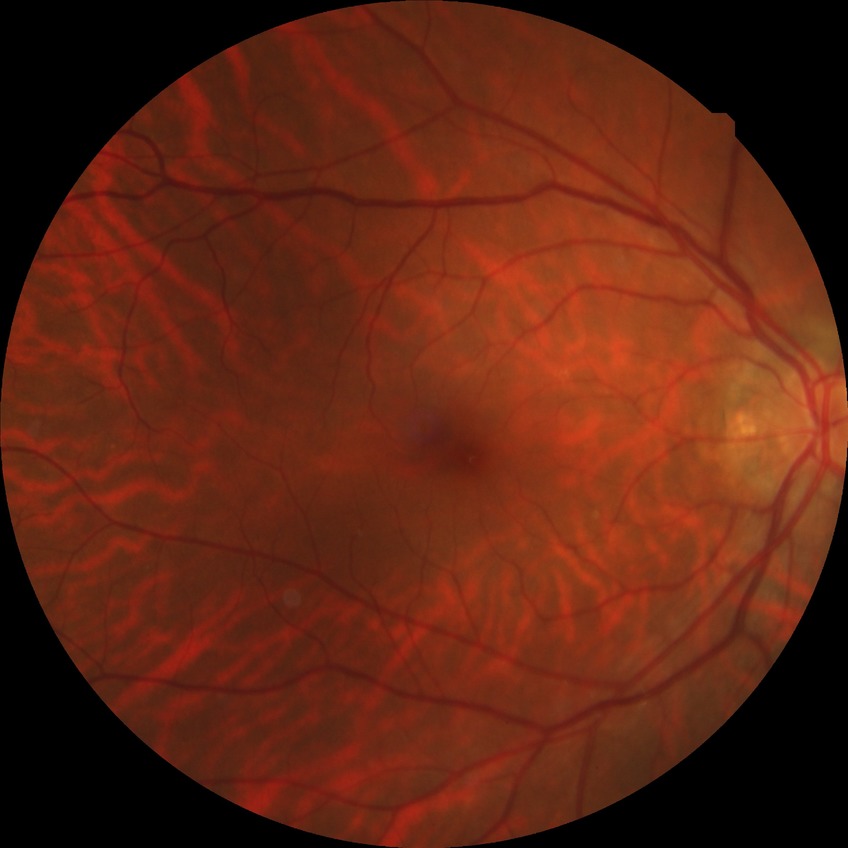
Diabetic retinopathy stage: no diabetic retinopathy.